45° field of view. 1380x1382px. Fundus photo: 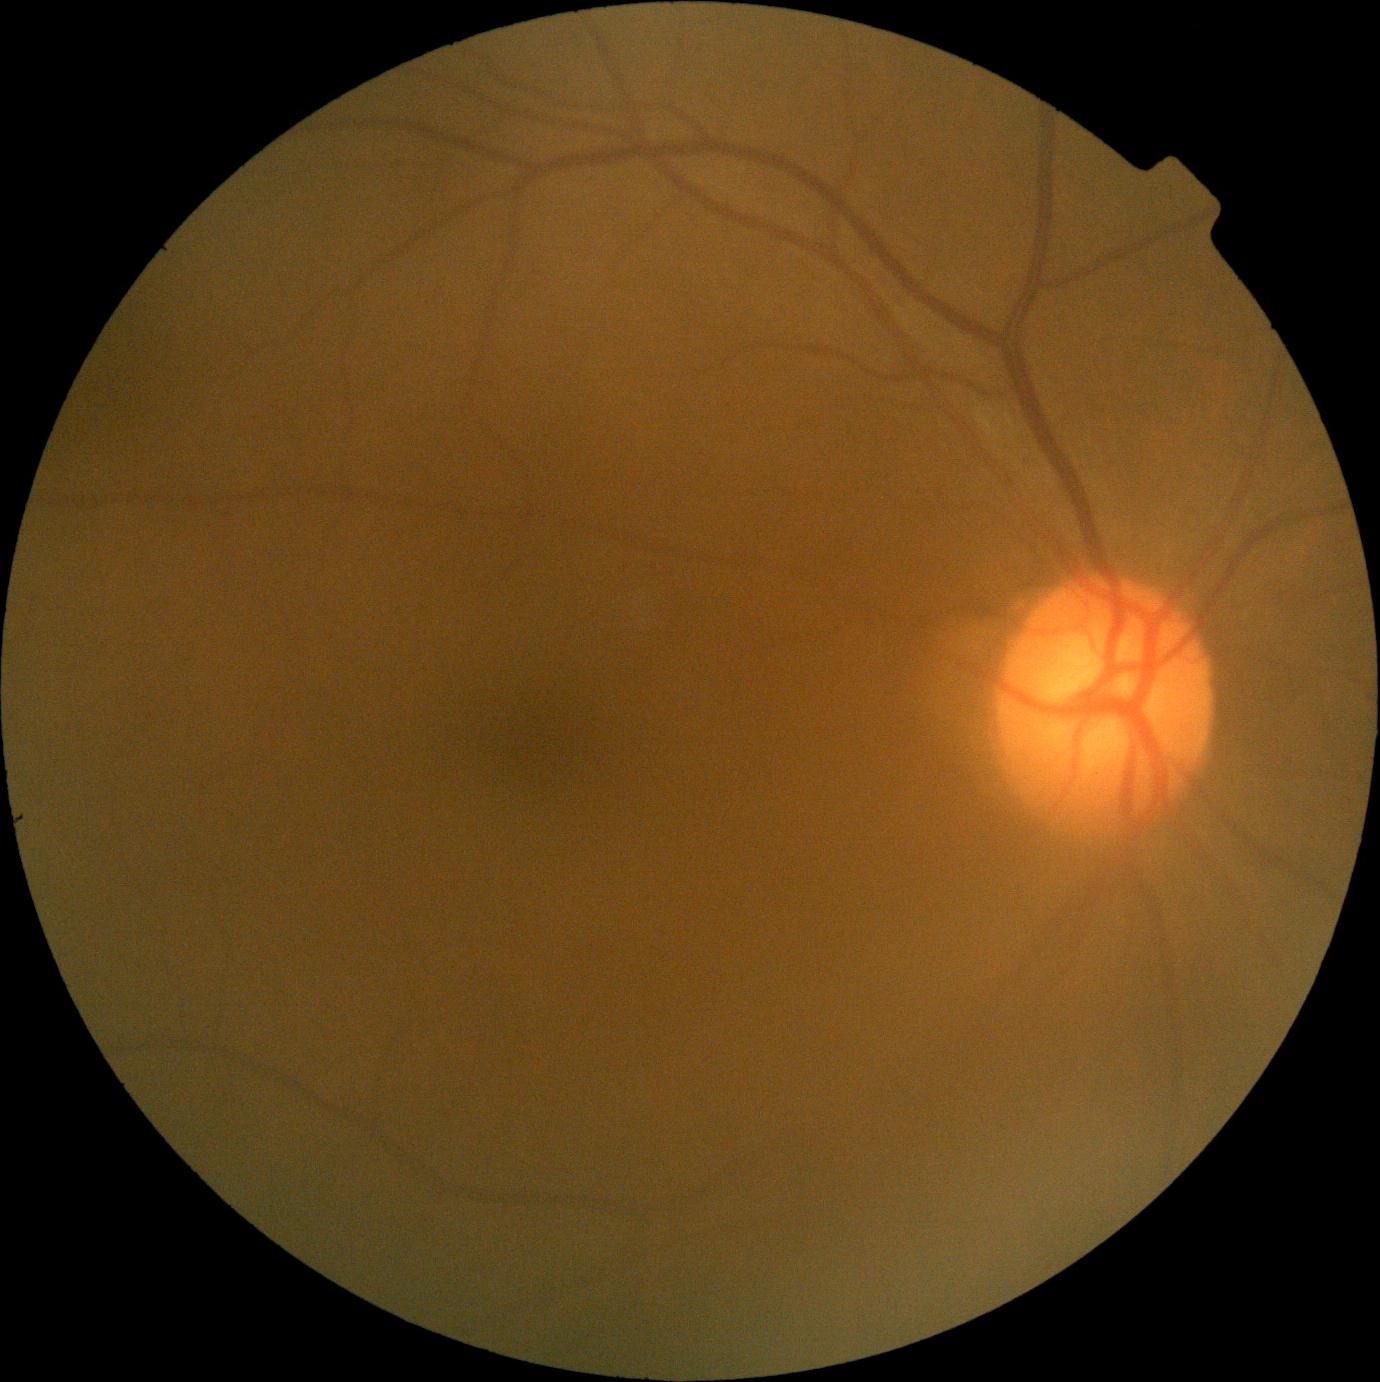 DR severity: grade 0 — no visible signs of diabetic retinopathy.
No diabetic retinal disease findings.